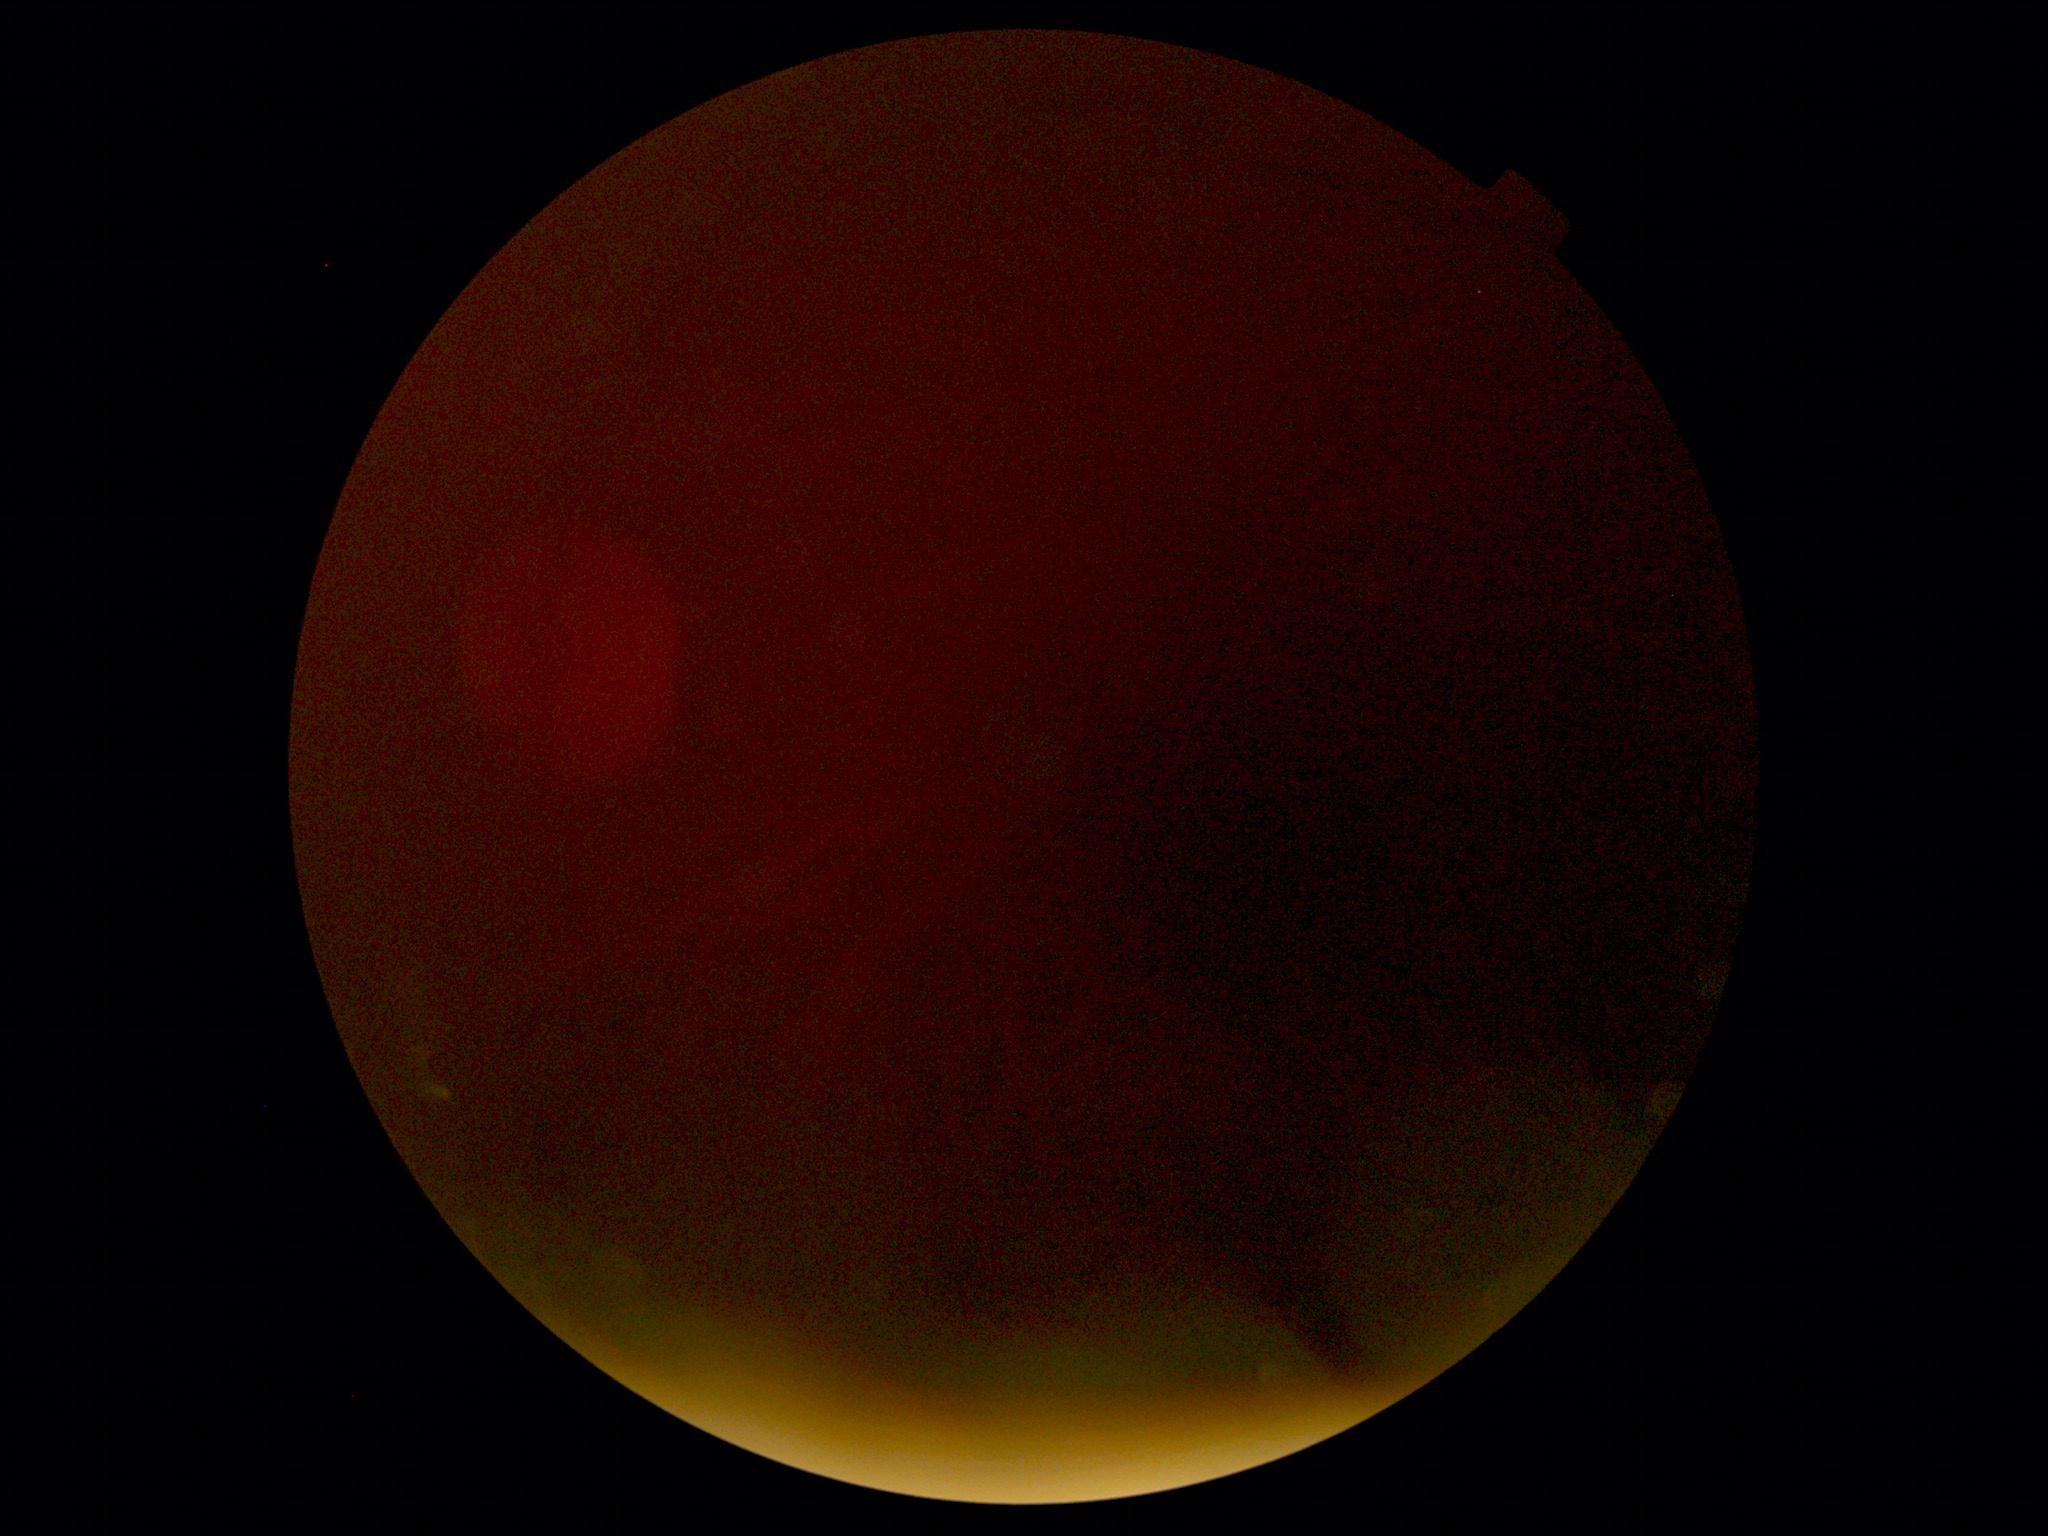
* DR stage — ungradable due to poor image quality